Image size 848x848
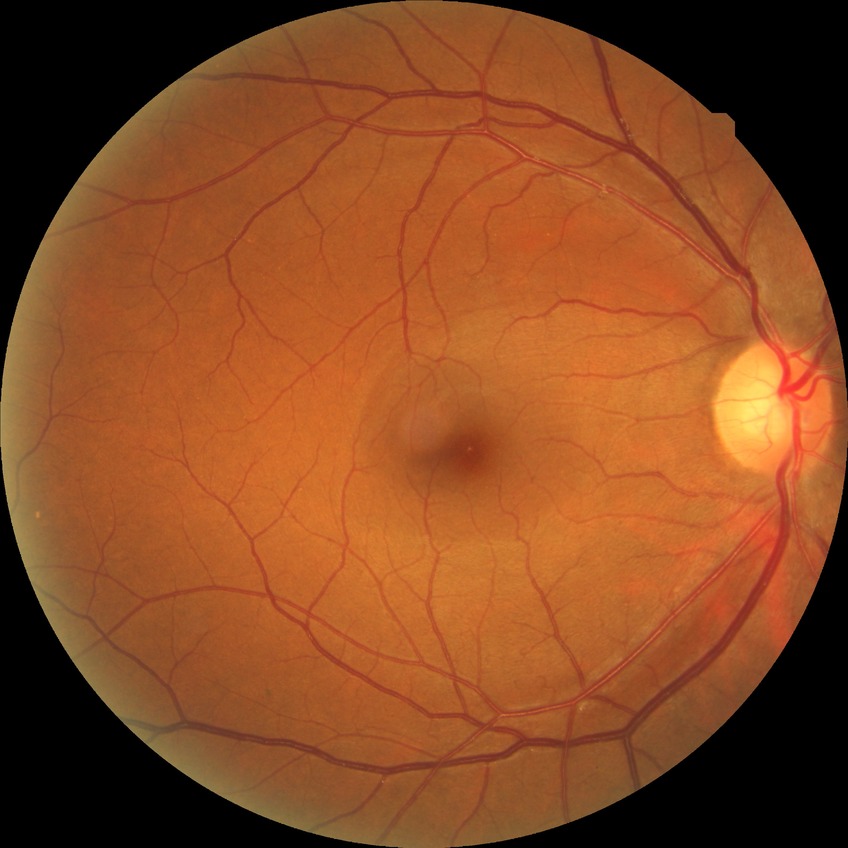
{"davis_grade": "no diabetic retinopathy (NDR)"}